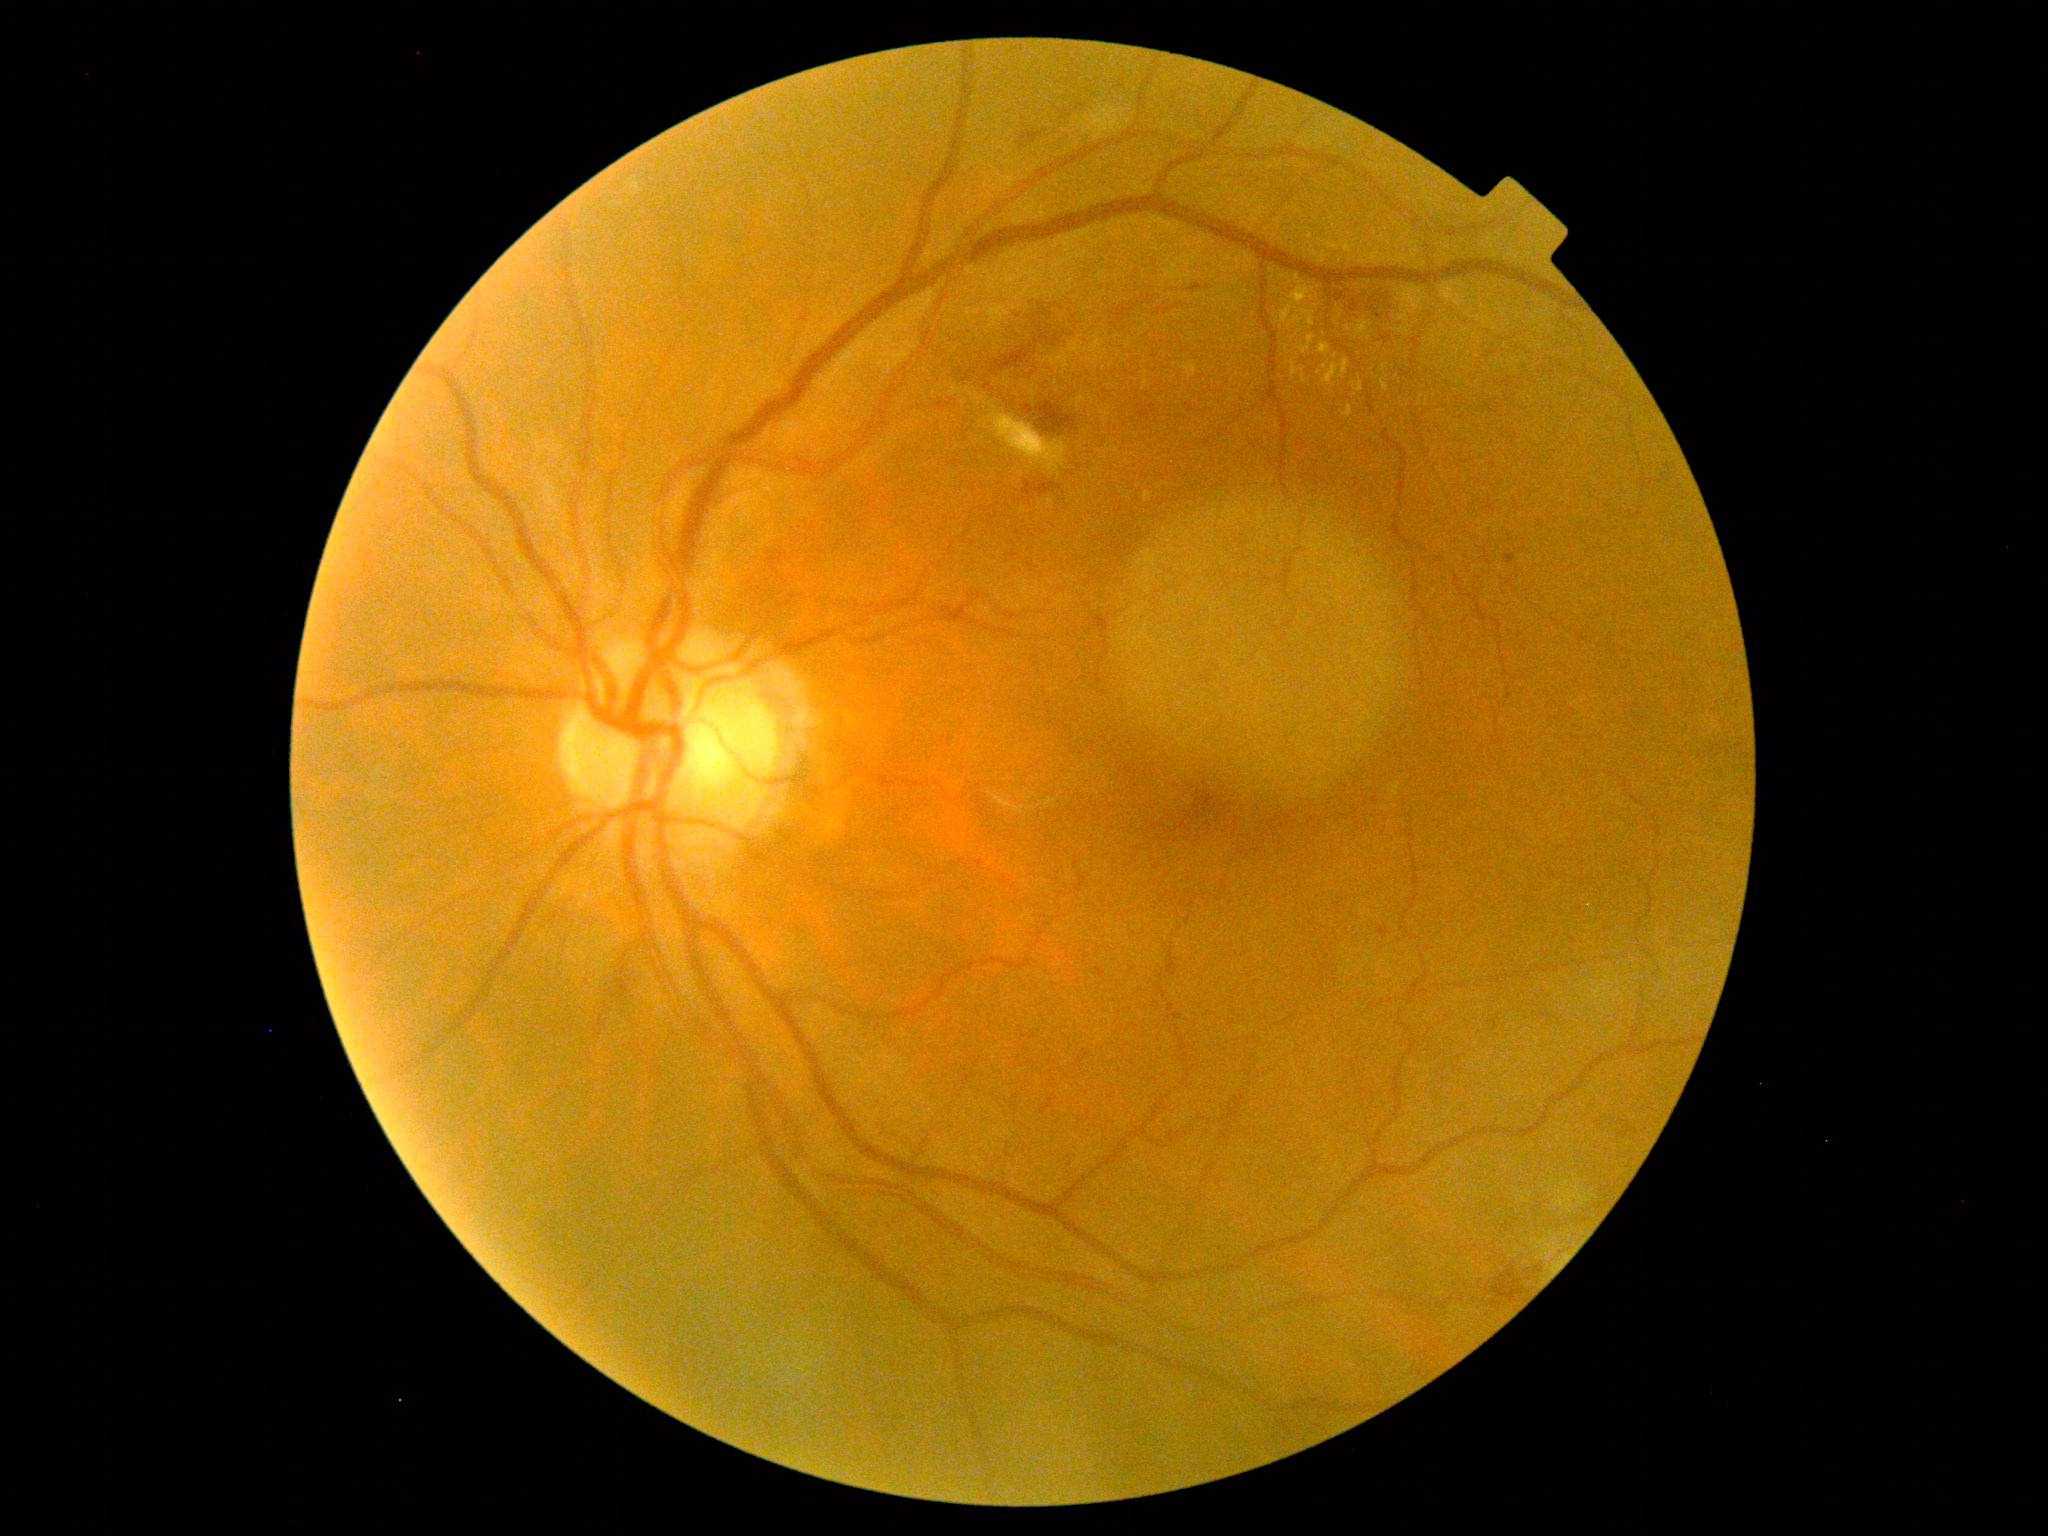

DR stage = 2/4.